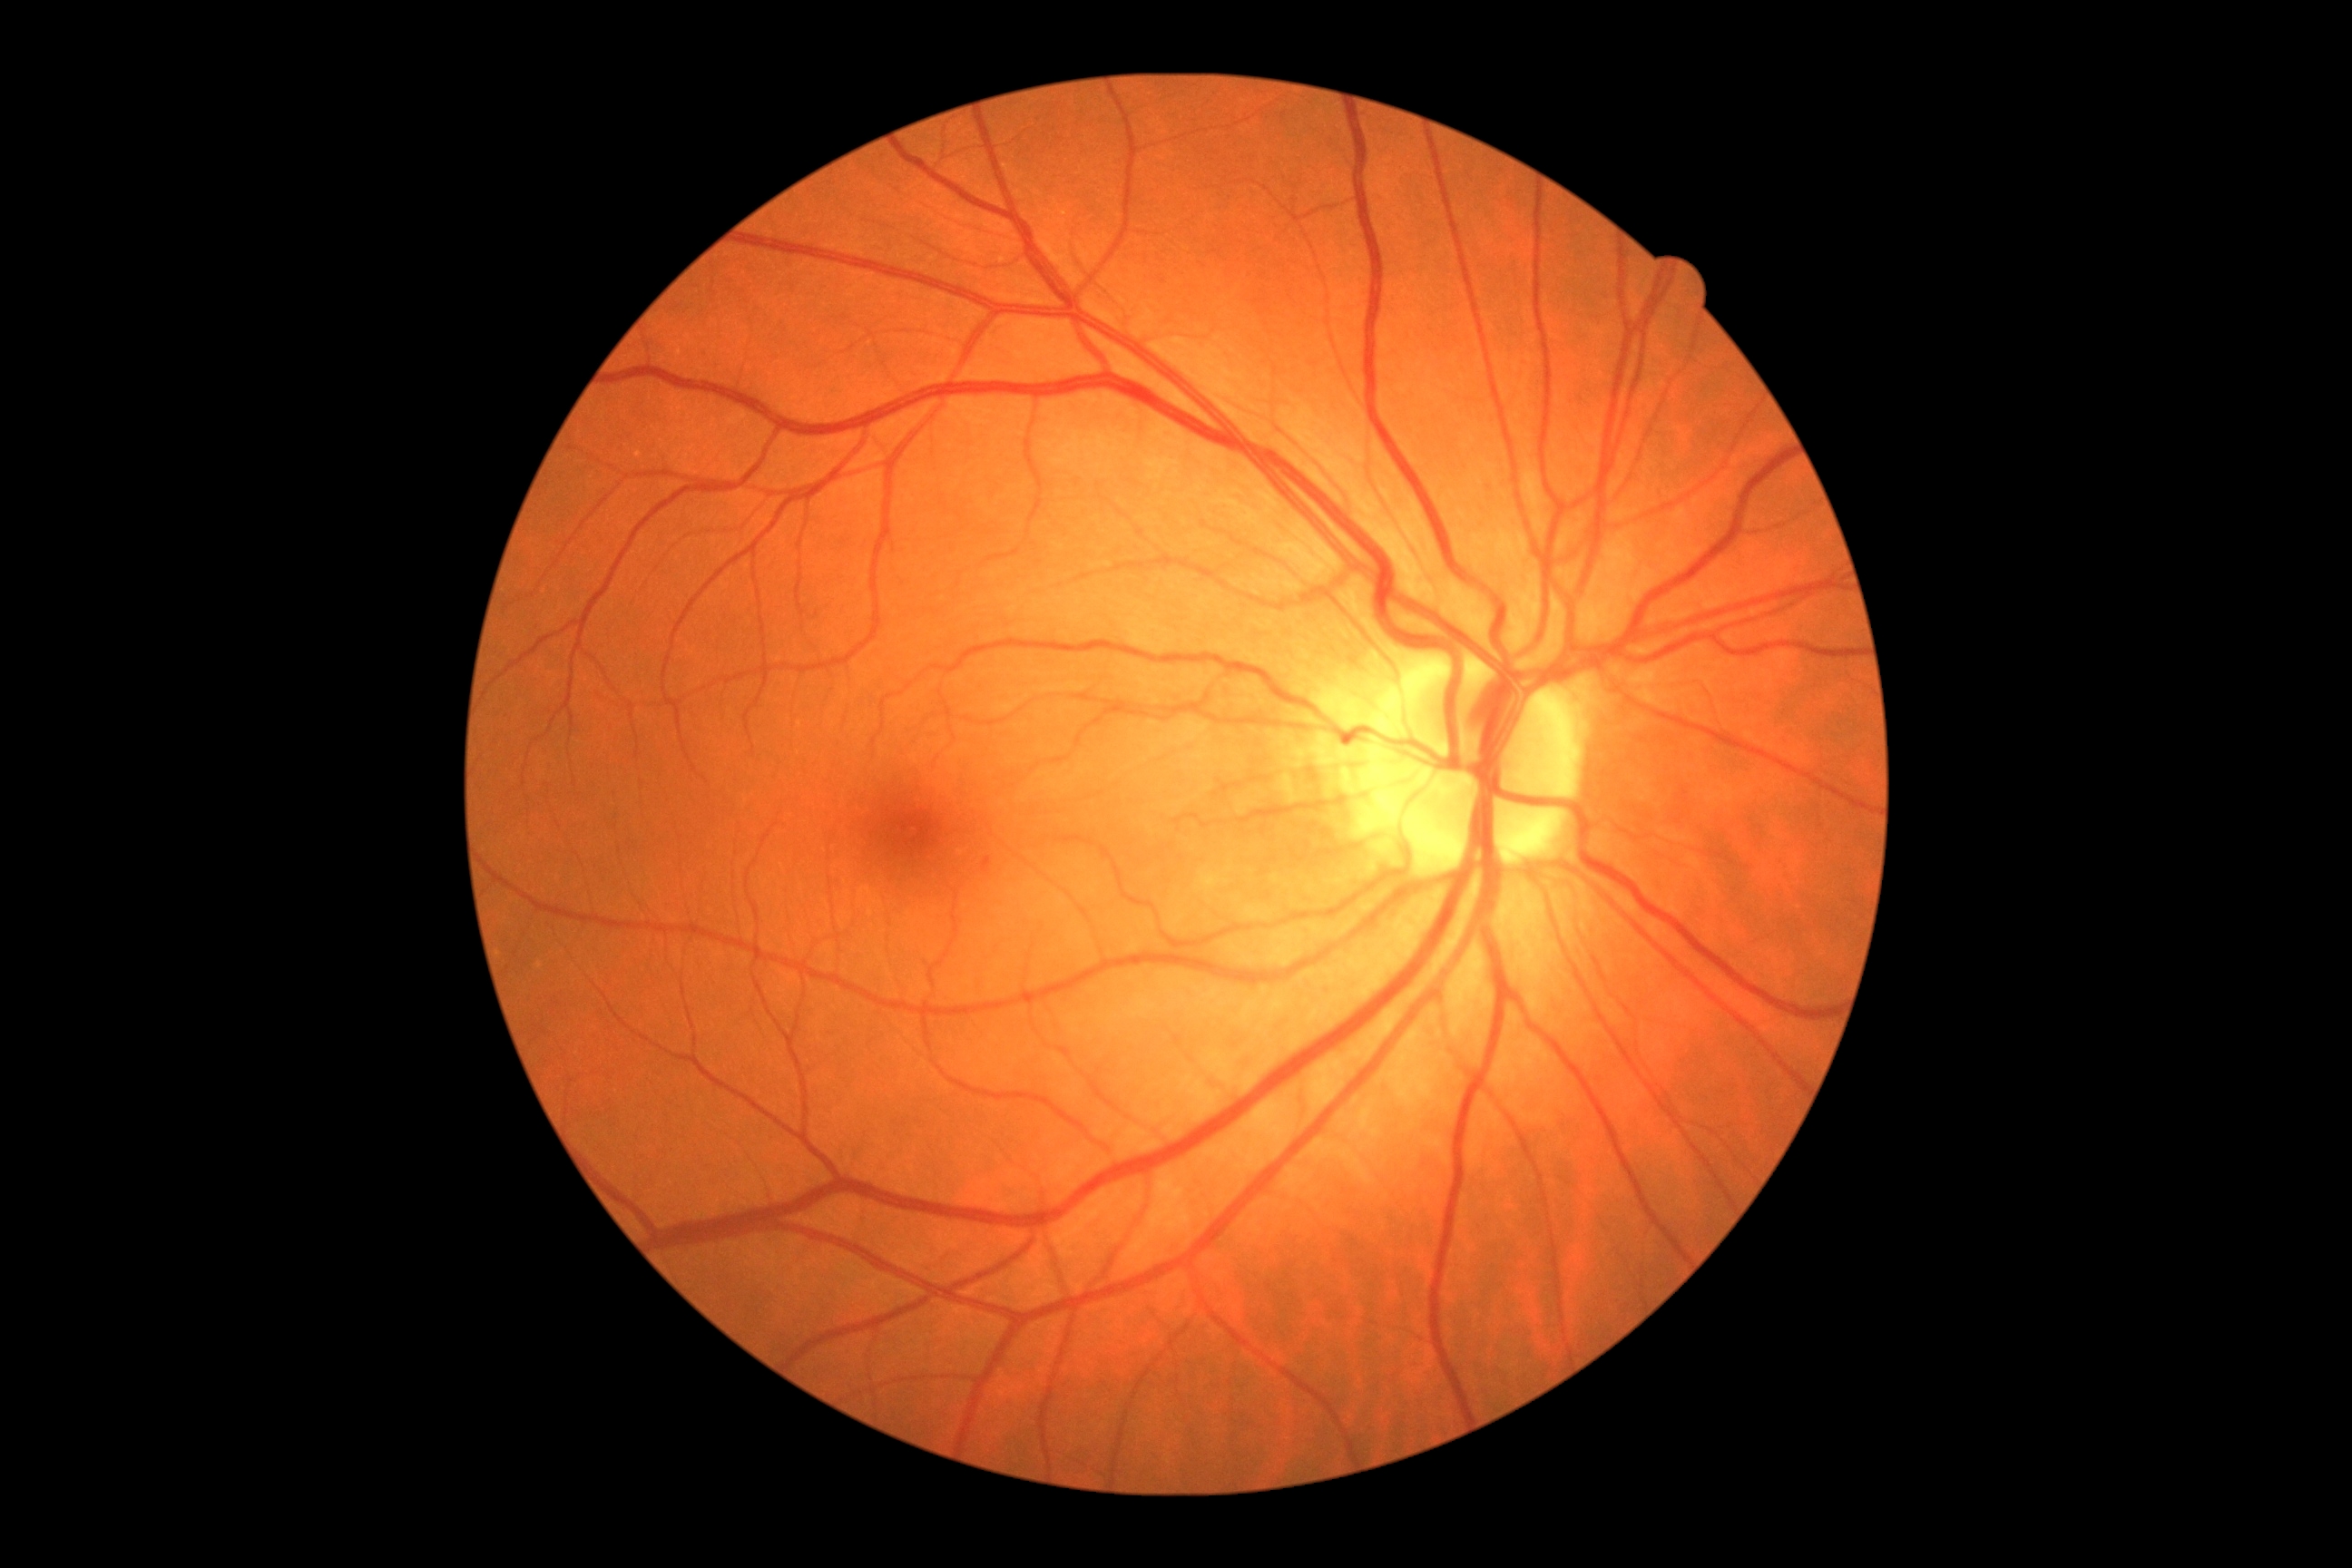 DR@grade 1 (mild NPDR) — presence of microaneurysms only.